Image size 2212x1659 — 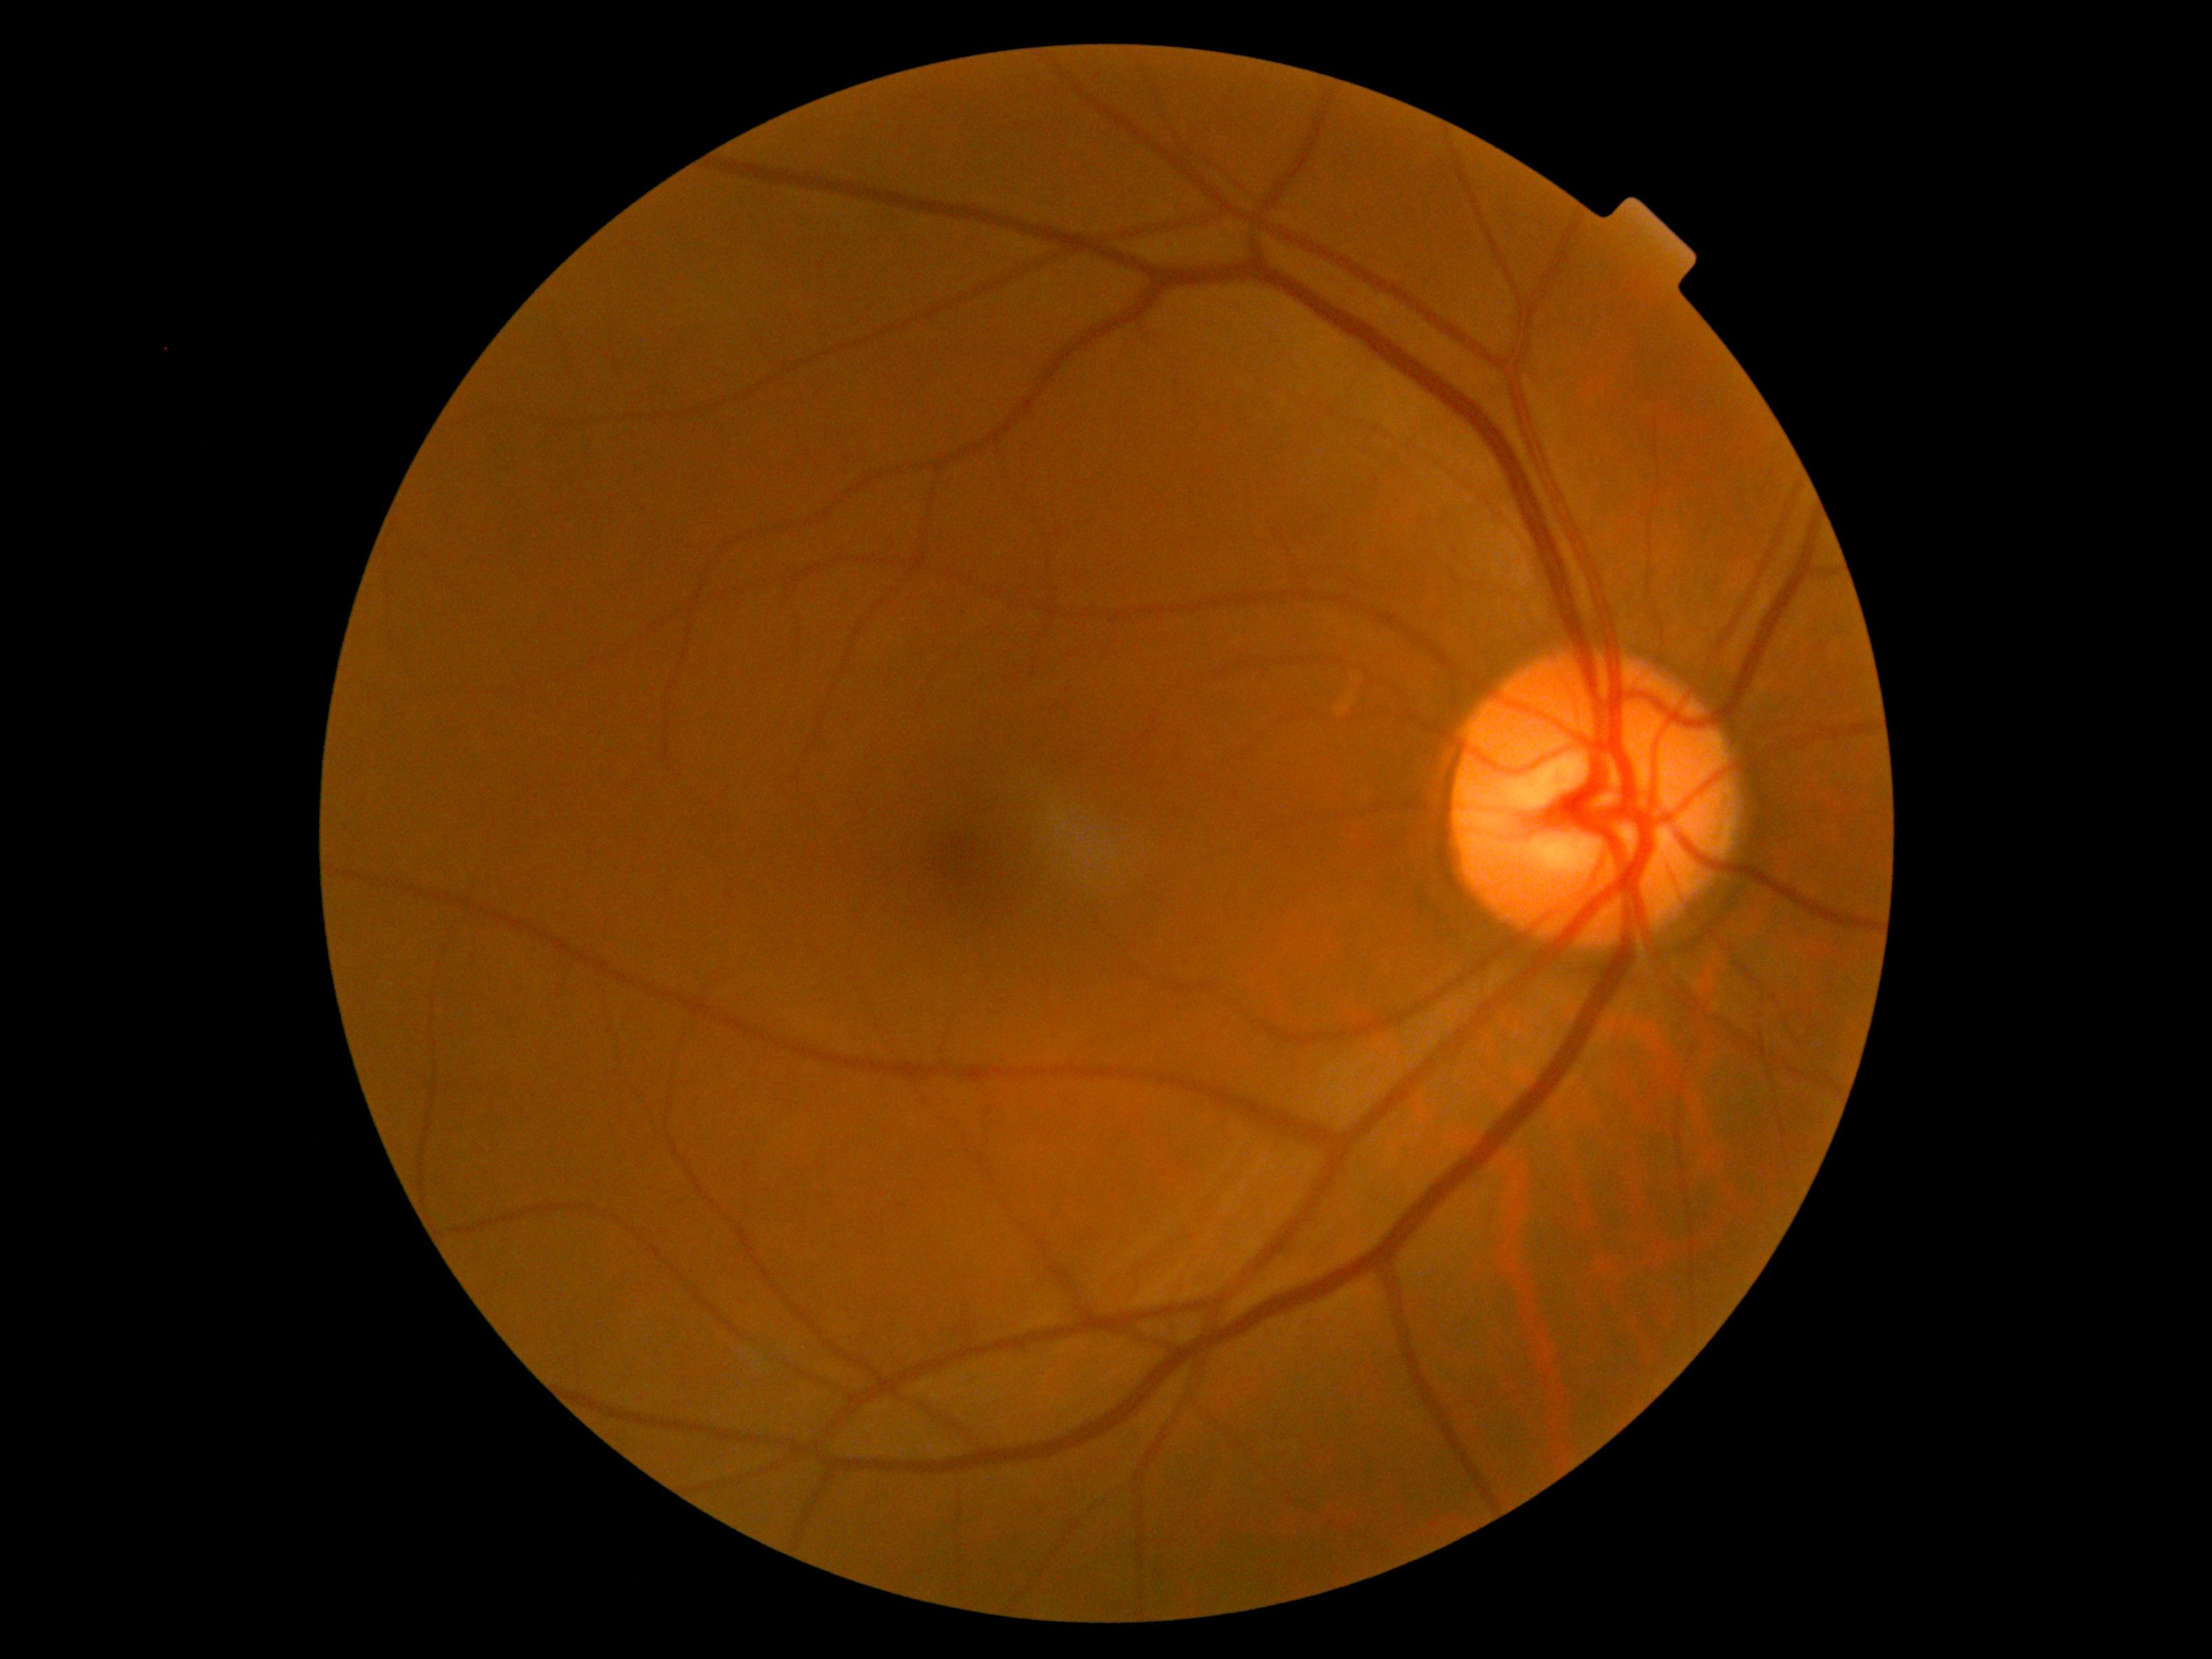 DR severity is 0/4 — no visible signs of diabetic retinopathy. No signs of diabetic retinopathy.